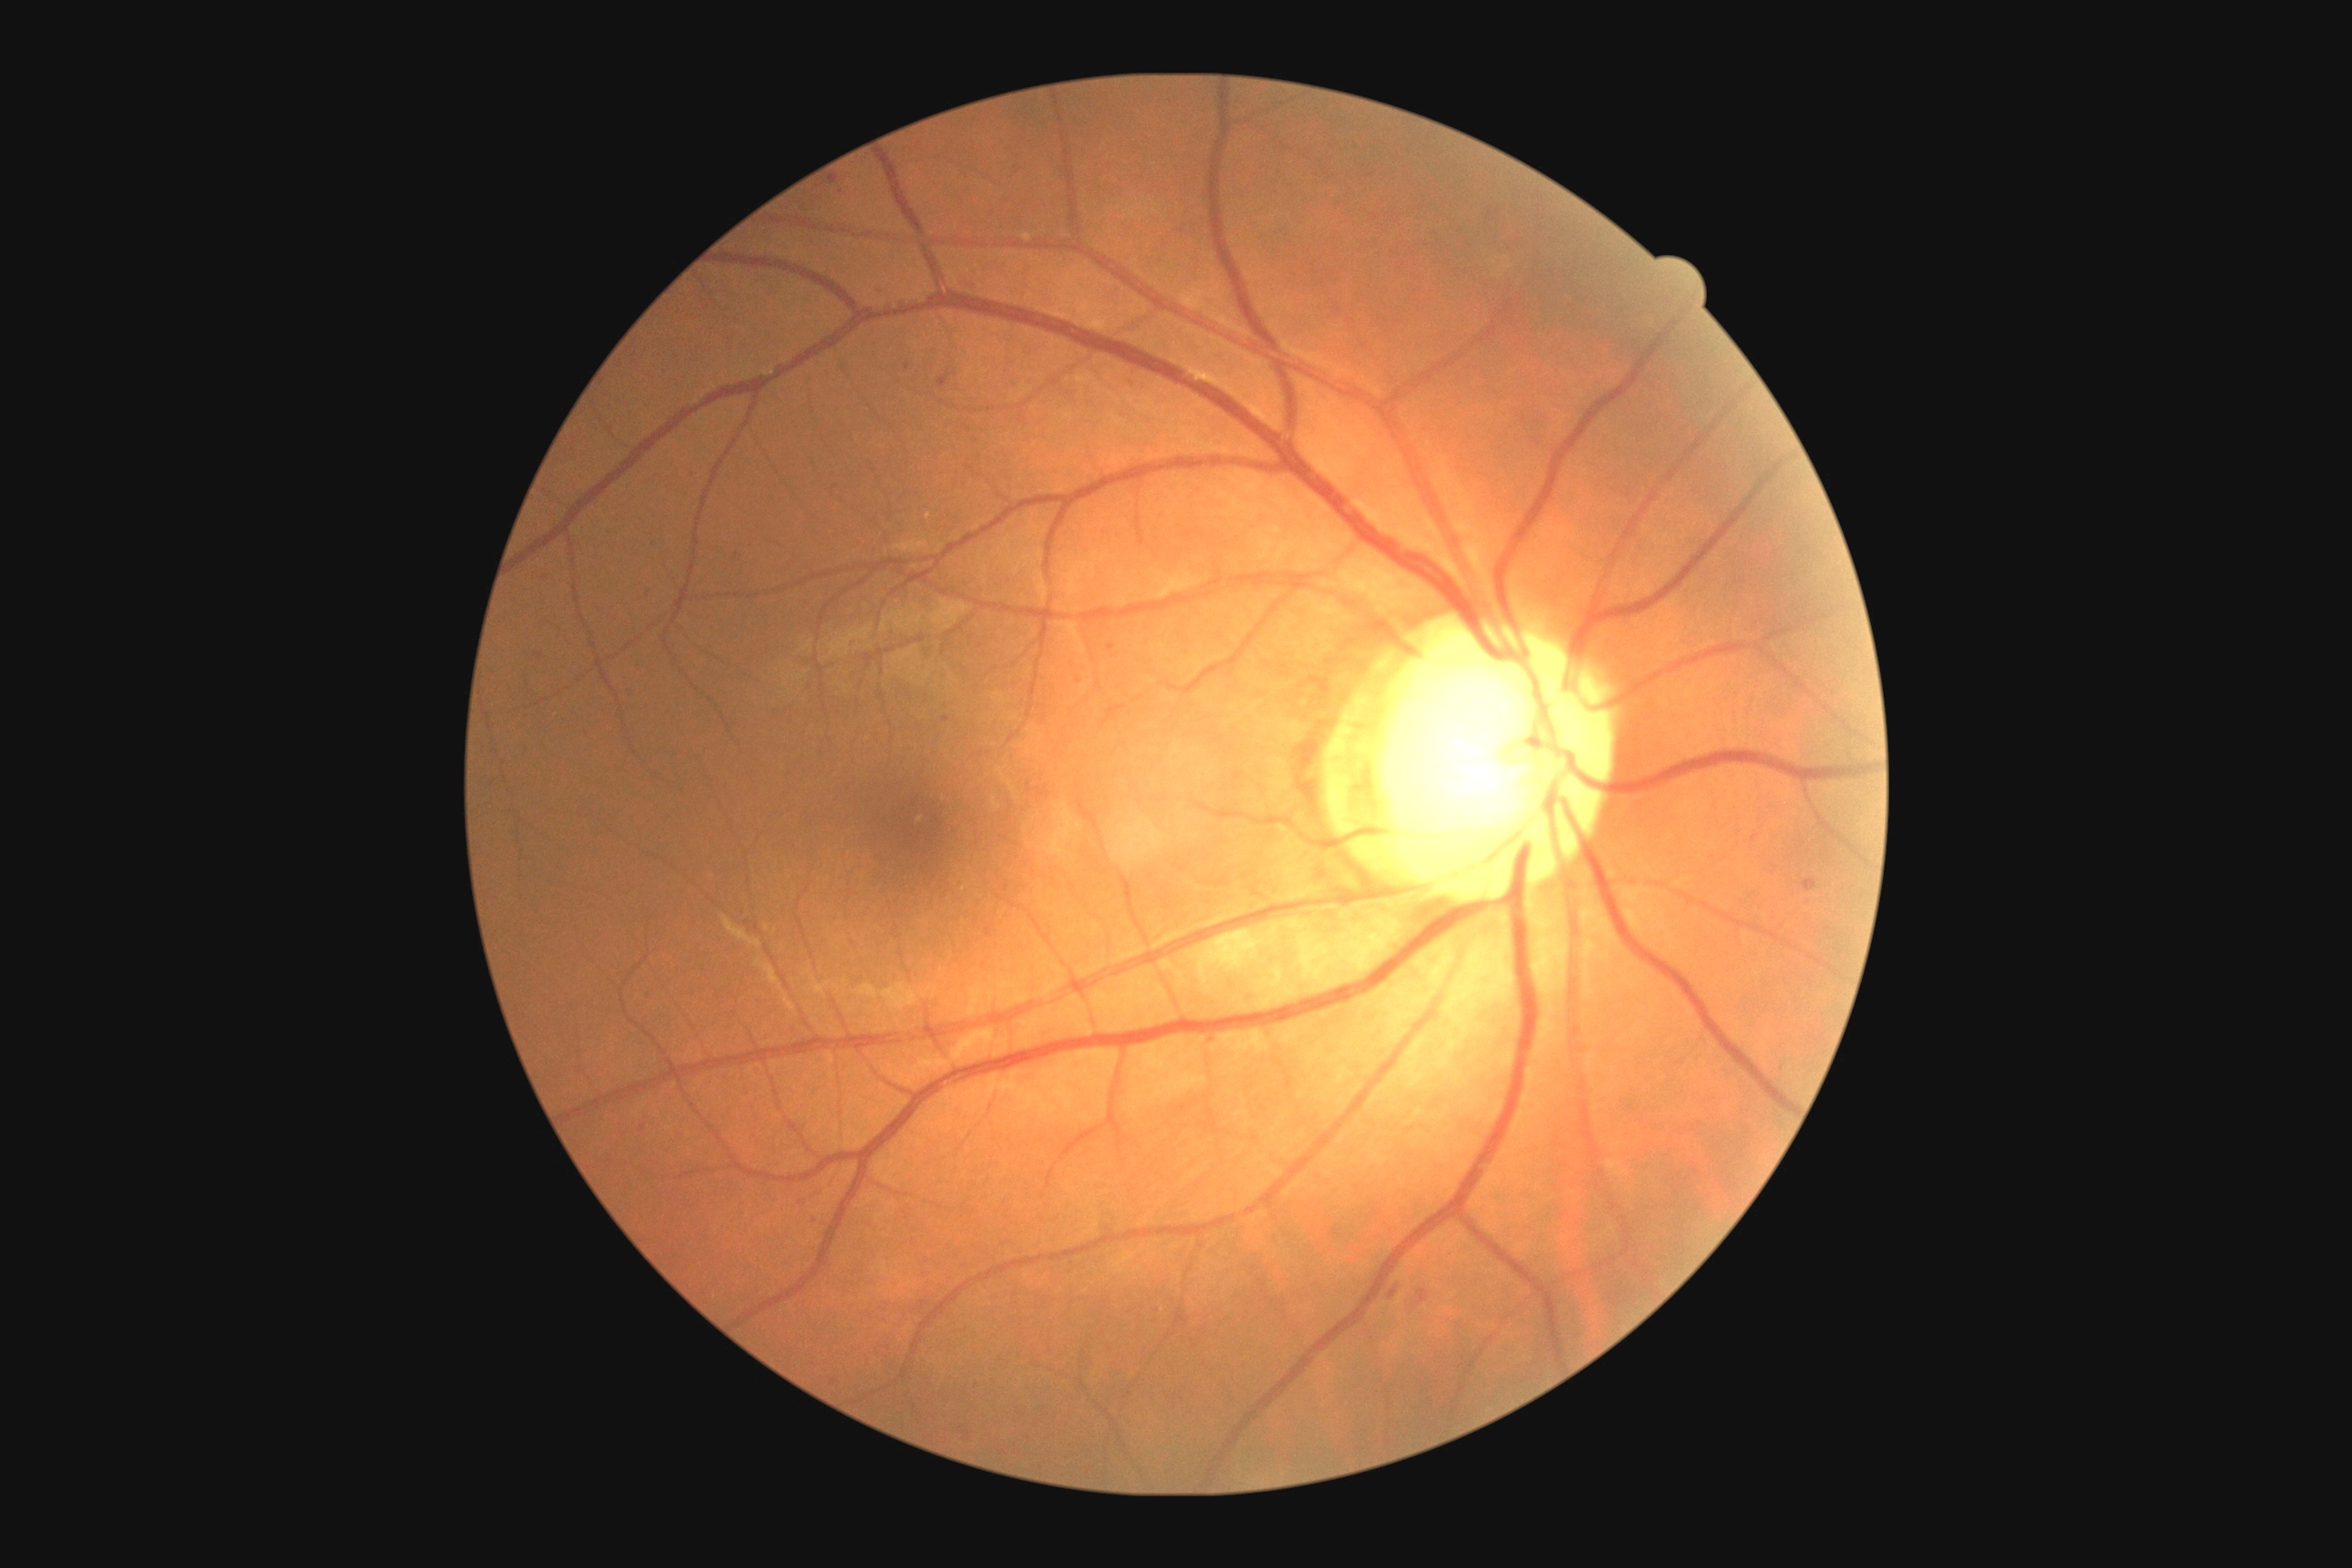
Diabetic retinopathy severity is 1/4
Selected lesions:
microaneurysms: (939,375,950,387) | (1803,877,1818,892) | (872,288,888,299) | (830,177,839,184)
Small microaneurysms near Point(946, 719) | Point(841, 191) | Point(908, 366) | Point(955, 374)
hard exudates: none identified
soft exudates: none identified
hemorrhages (continued): (645,992,654,1001) | (536,654,544,660) | (1416,1289,1427,1306) | (1389,1282,1402,1300) | (812,1217,821,1226)